Wide-field contact fundus photograph of an infant
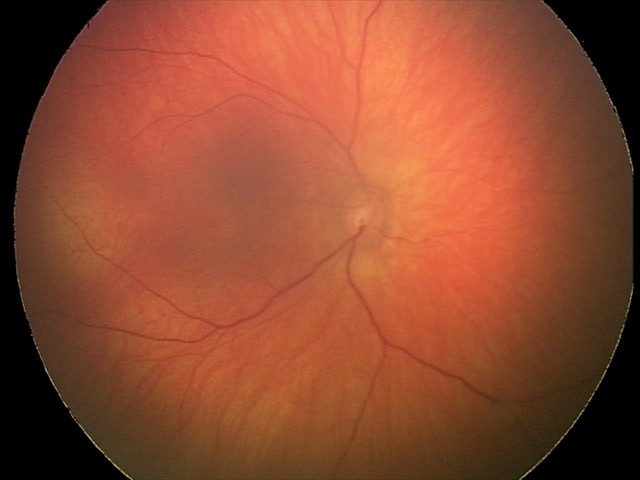

Screening series with retinal hemorrhages.